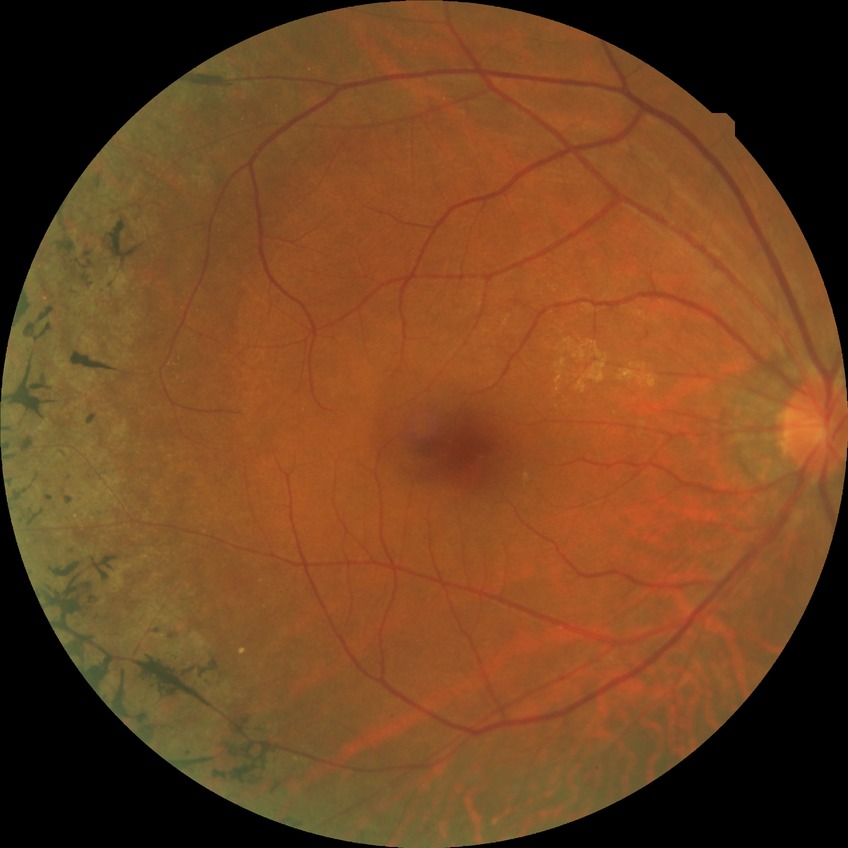
diabetic retinopathy (DR)=no diabetic retinopathy (NDR).